DR severity per modified Davis staging.
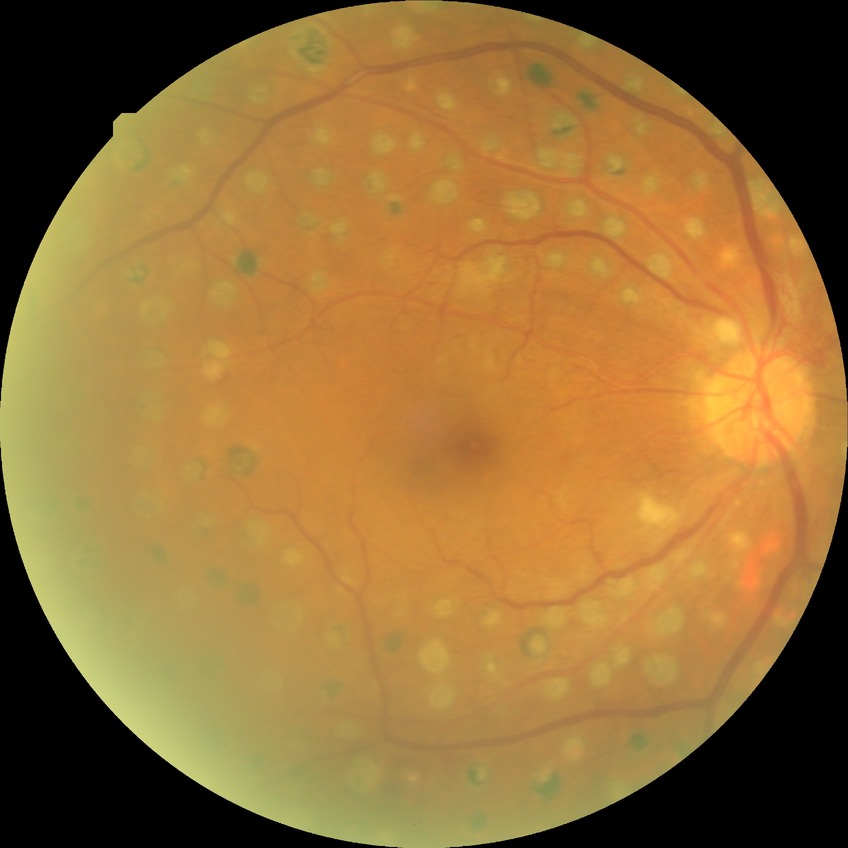
Davis stage is PDR.